Nidek AFC-330, color fundus image, cropped to the optic nerve head
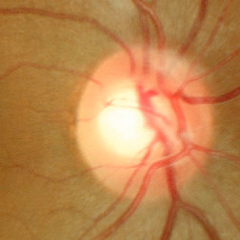
There is evidence of no signs of glaucoma.